Captured on a Topcon TRC-50DX fundus camera, retinal fundus photograph, 50° field of view:
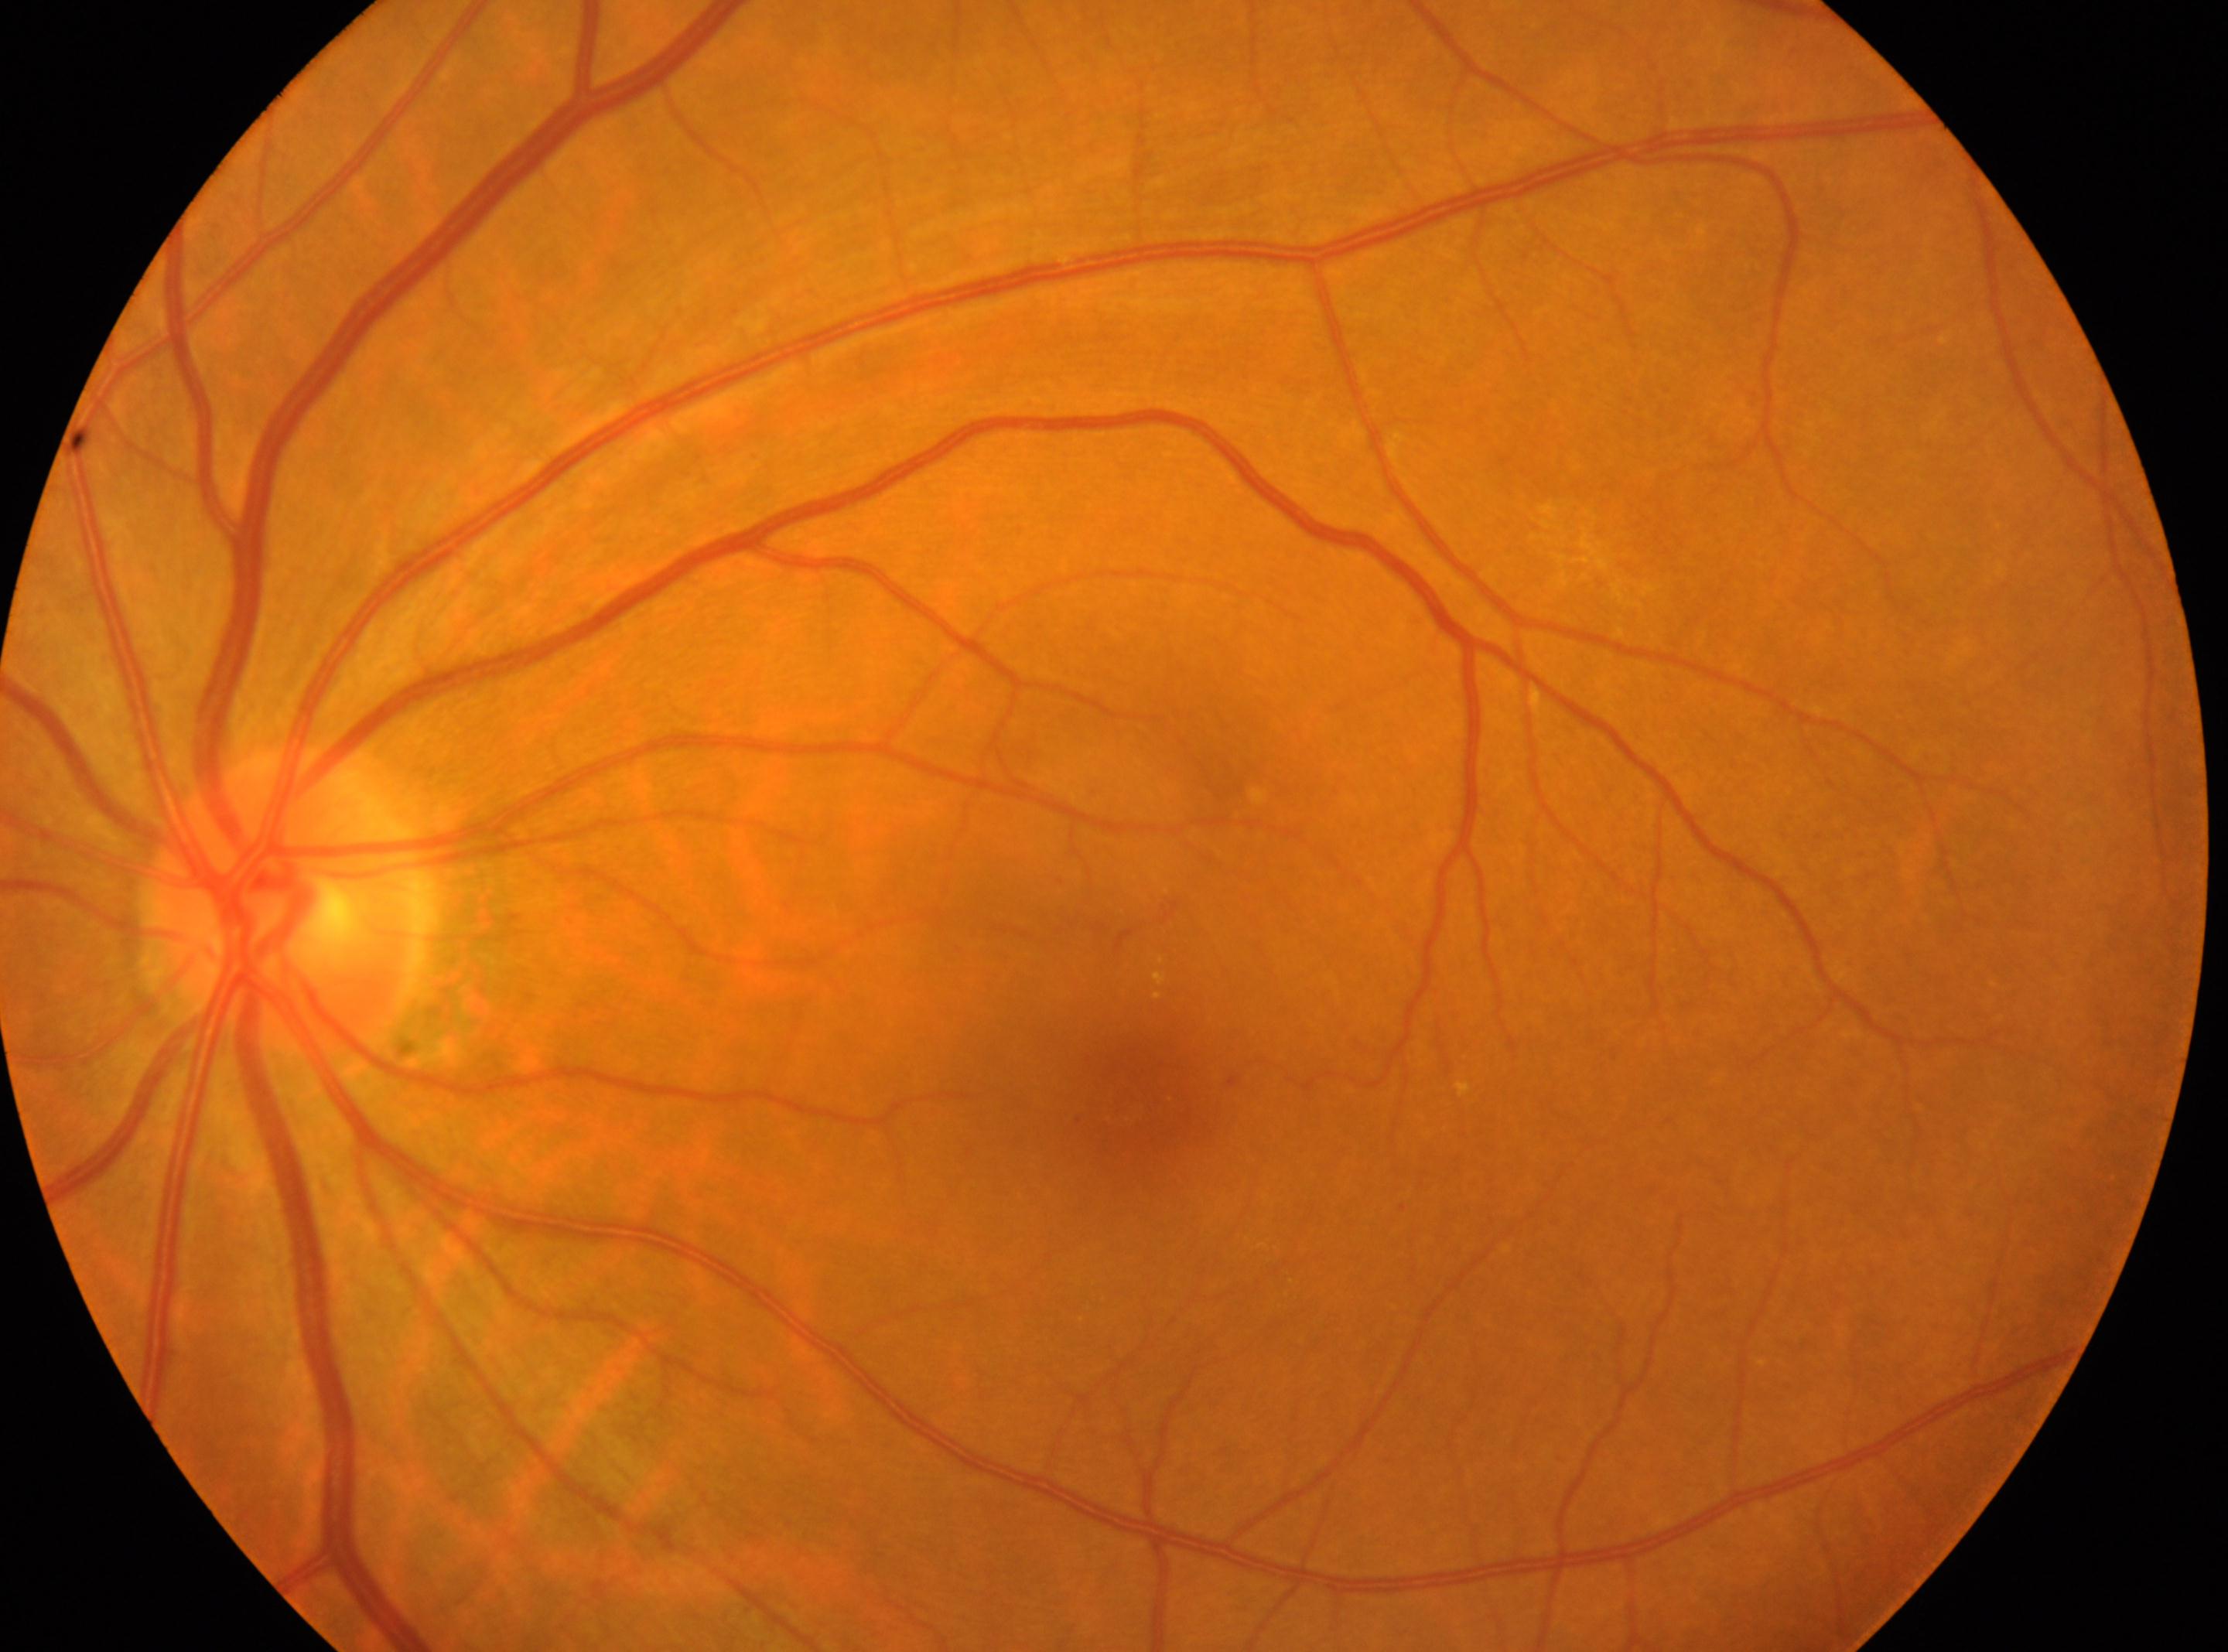 Fovea: 1123, 1106.
This is the left eye.
The optic nerve head is at 279, 903.
Retinopathy grade: moderate NPDR (2).